45-degree field of view; no pharmacologic dilation.
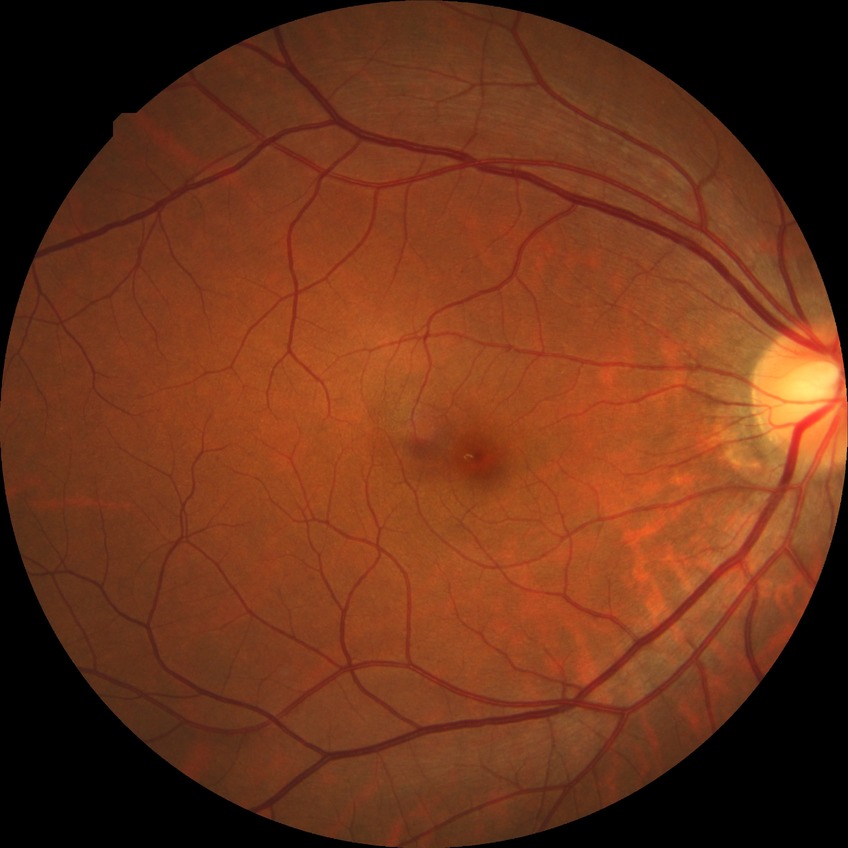
  davis_grade: no diabetic retinopathy